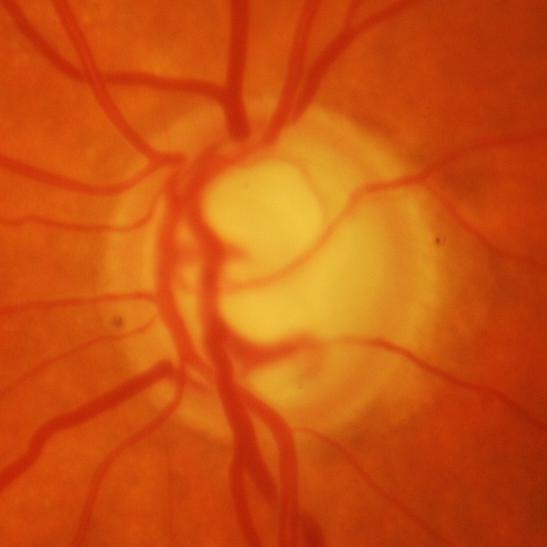
Glaucoma.